848x848. Davis DR grading
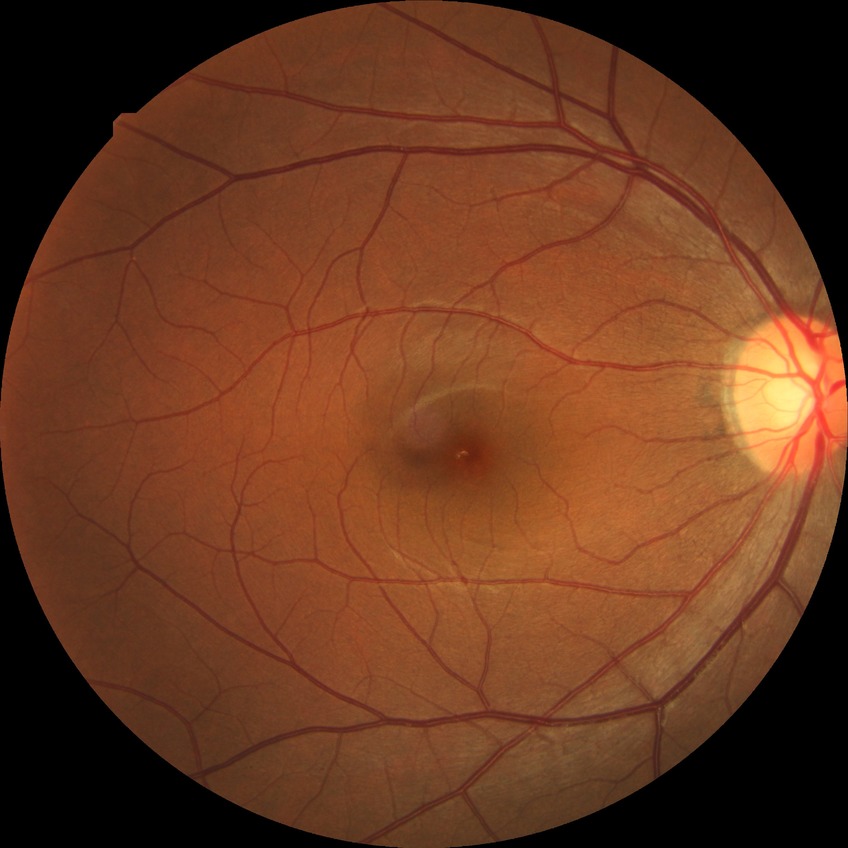
modified Davis classification: no diabetic retinopathy.